Cropped to the optic nerve head · captured without pupil dilation · fundus photo:
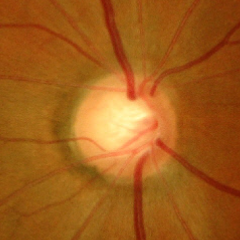
Advanced glaucomatous optic neuropathy.
Diagnostic criteria: near-total cupping of the optic nerve head, with or without severe visual field loss within the central 10 degrees of fixation.